Wide-field contact fundus photograph of an infant · 1240 by 1240 pixels
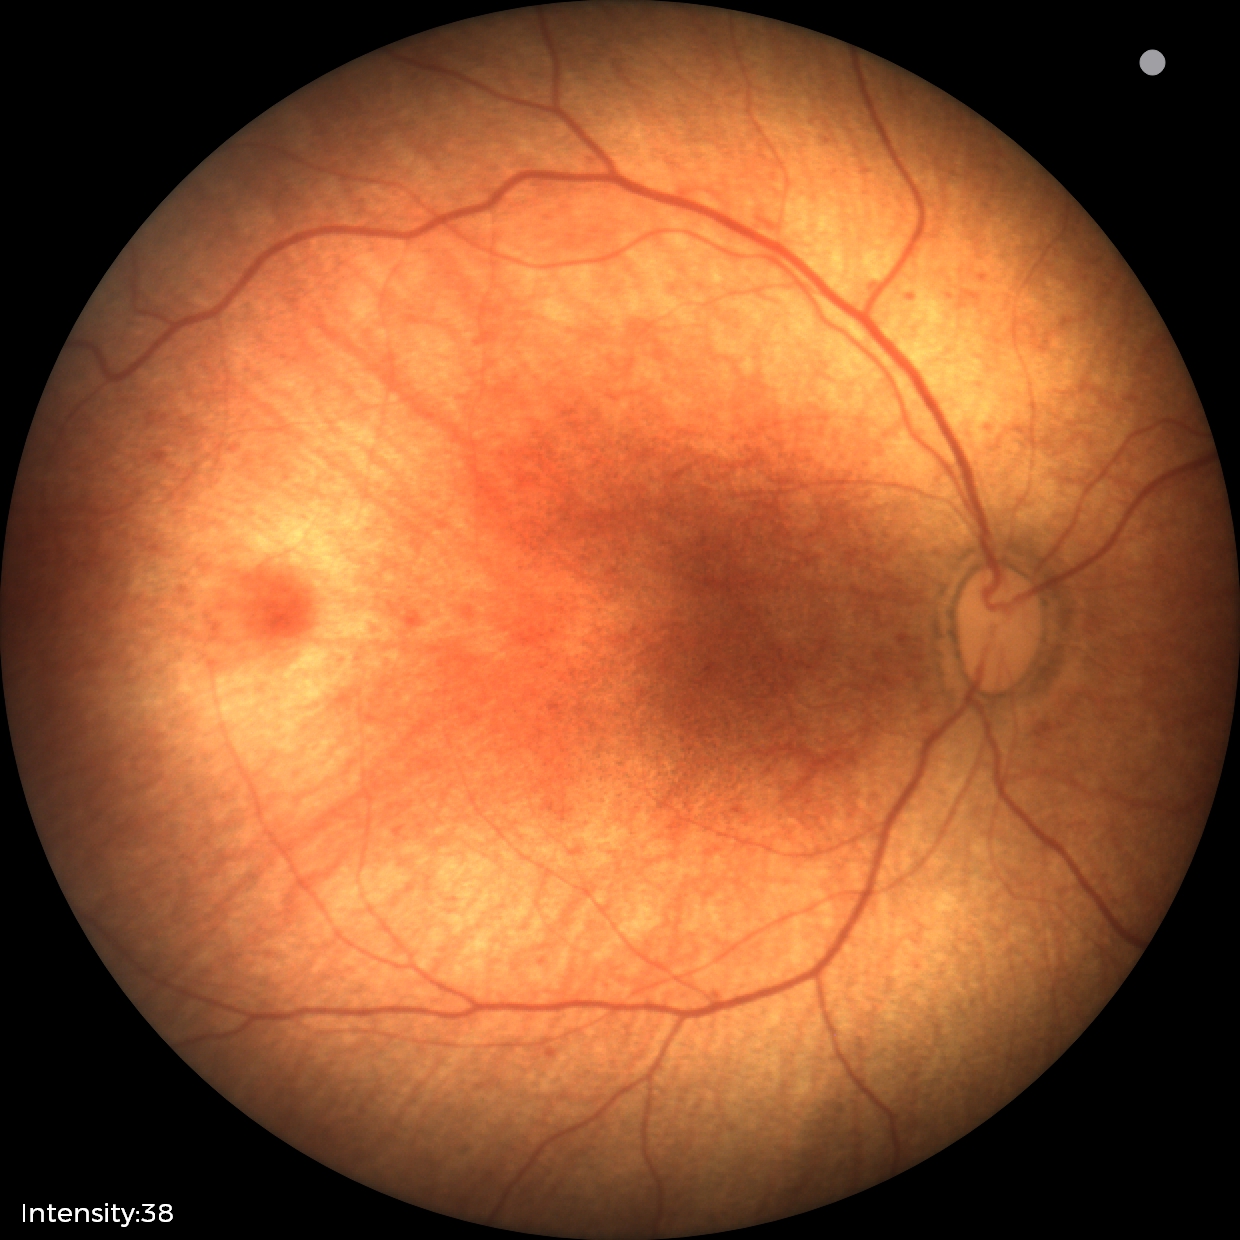
Screening examination with no abnormal retinal findings.